2228 by 1652 pixels · captured after pupil dilation · camera: Topcon TRC-50DX · retinal fundus photograph · 50-degree field of view · posterior pole field covering the optic disc and macula.
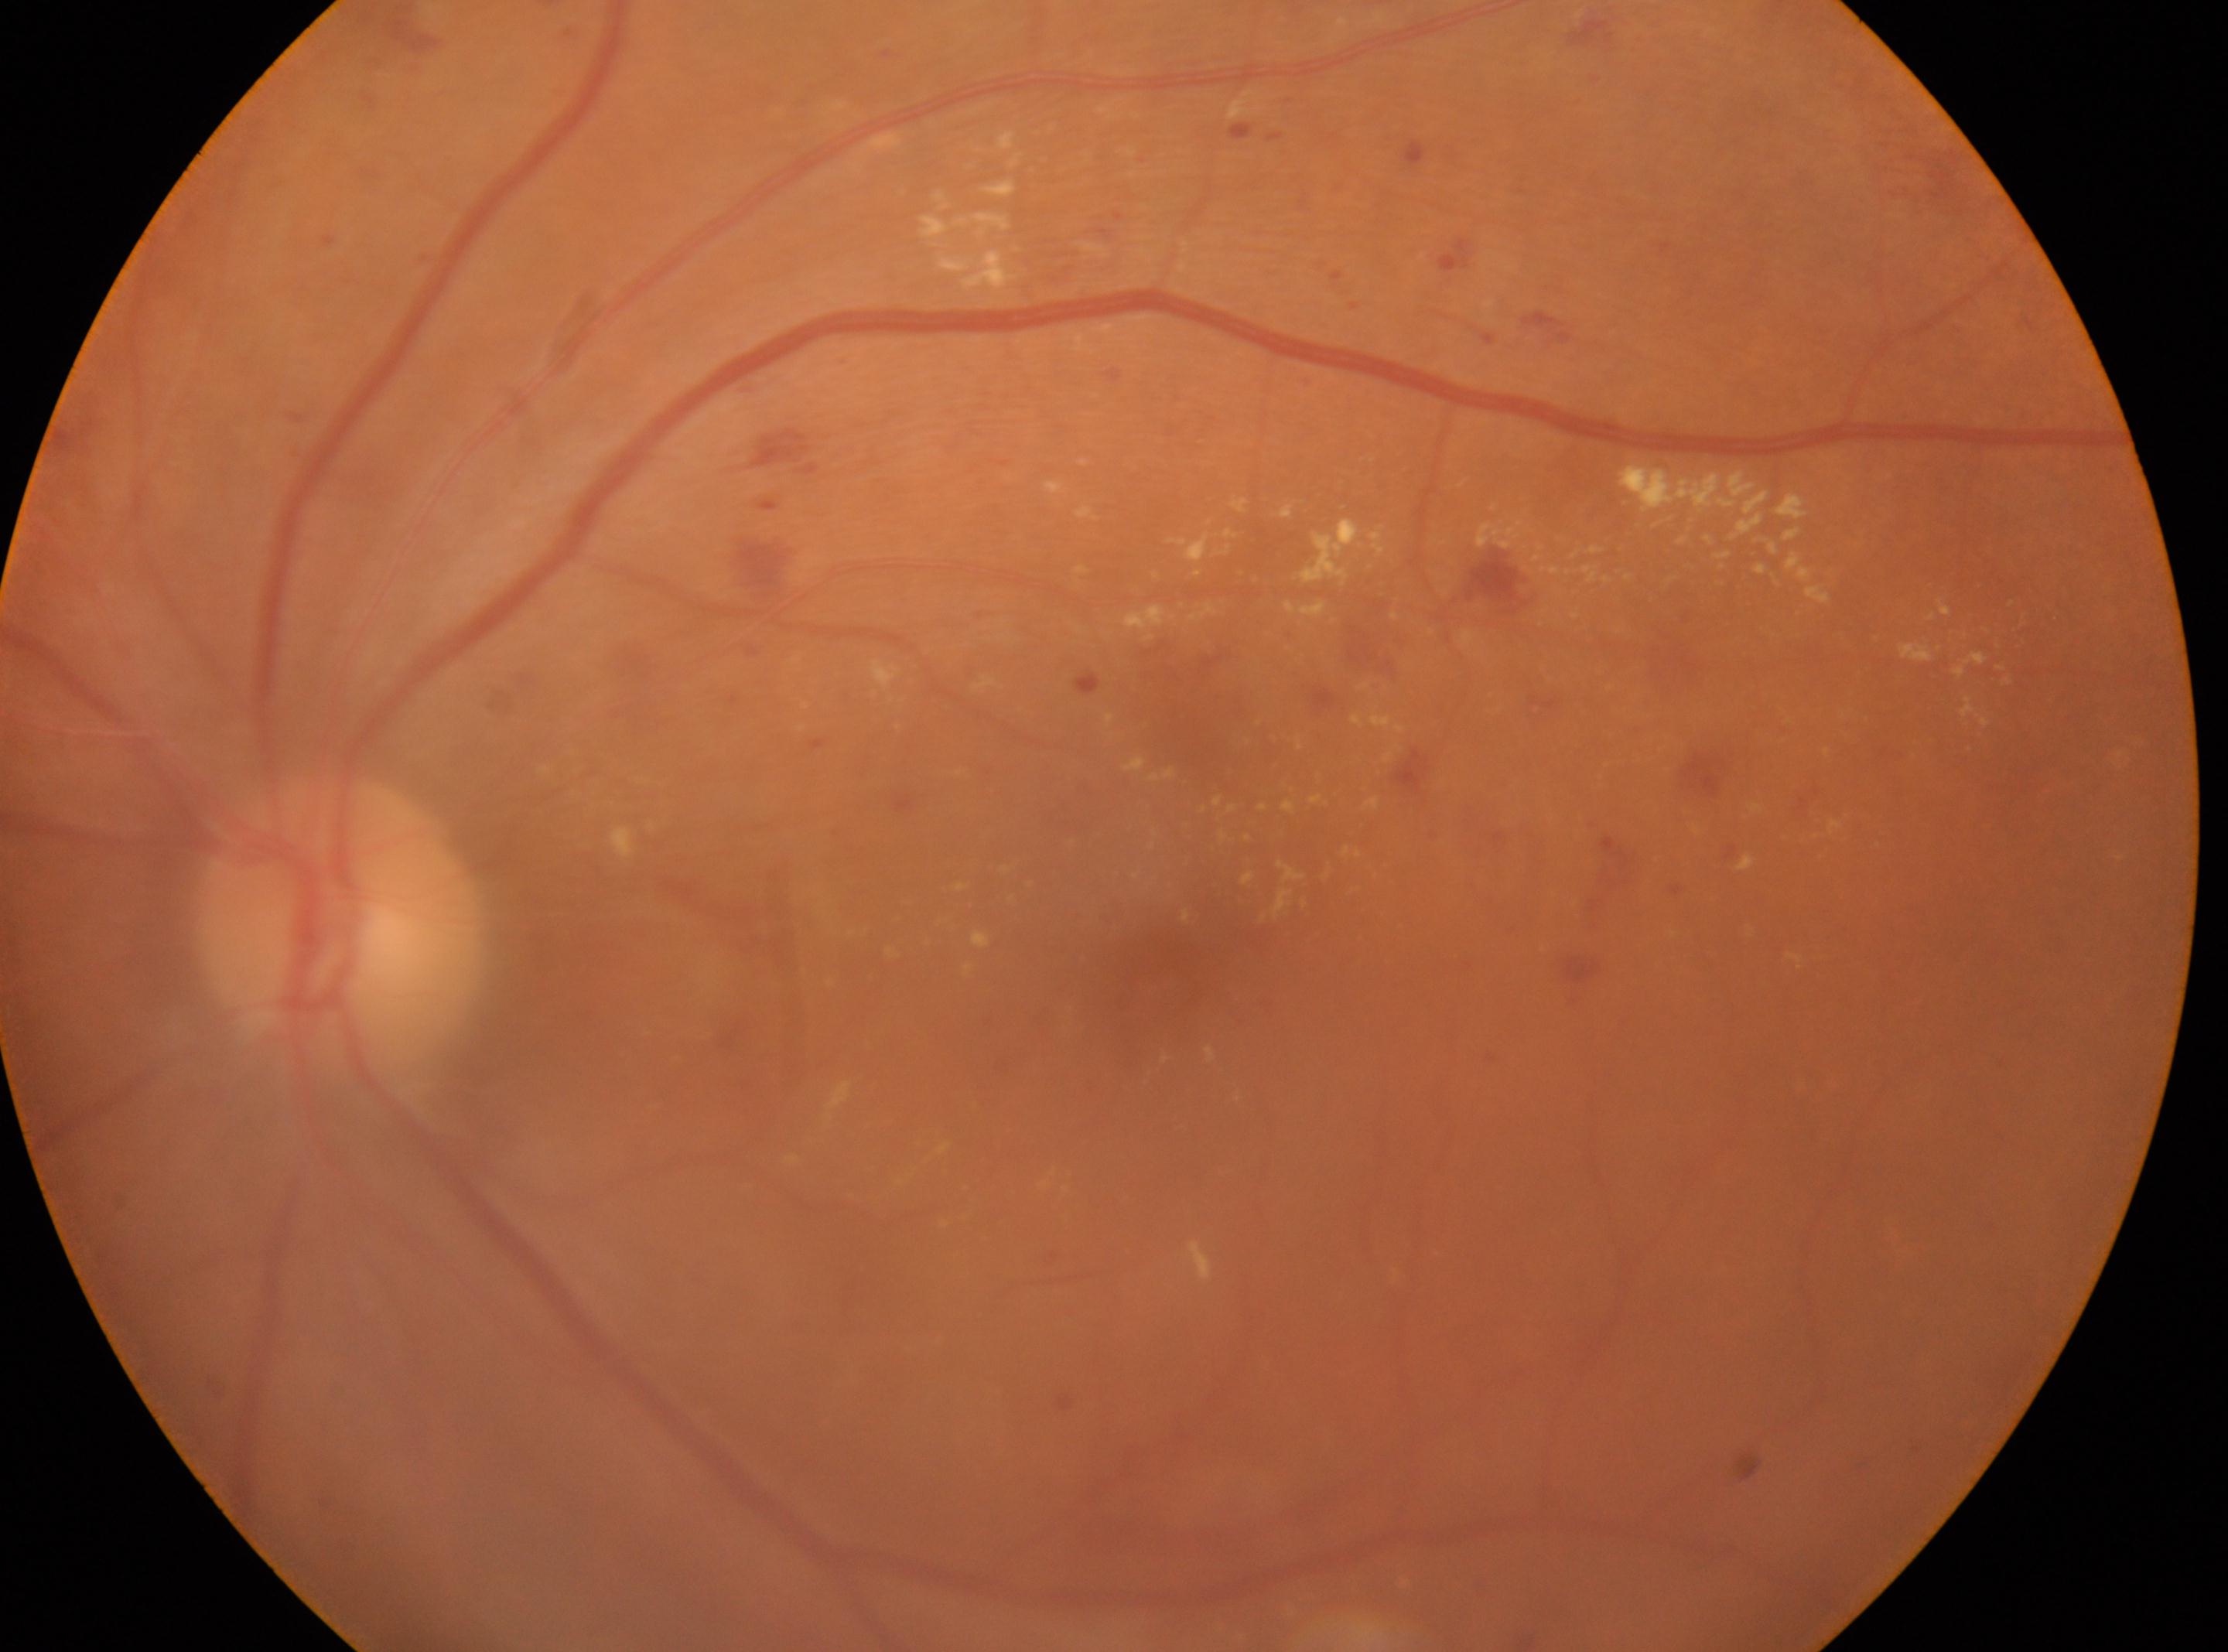 The macula center is at (1154, 985). Imaged eye: oculus sinister. The optic disc is at (337, 923). DR severity is 2/4.